1932x1916; FOV: 45 degrees; color fundus image — 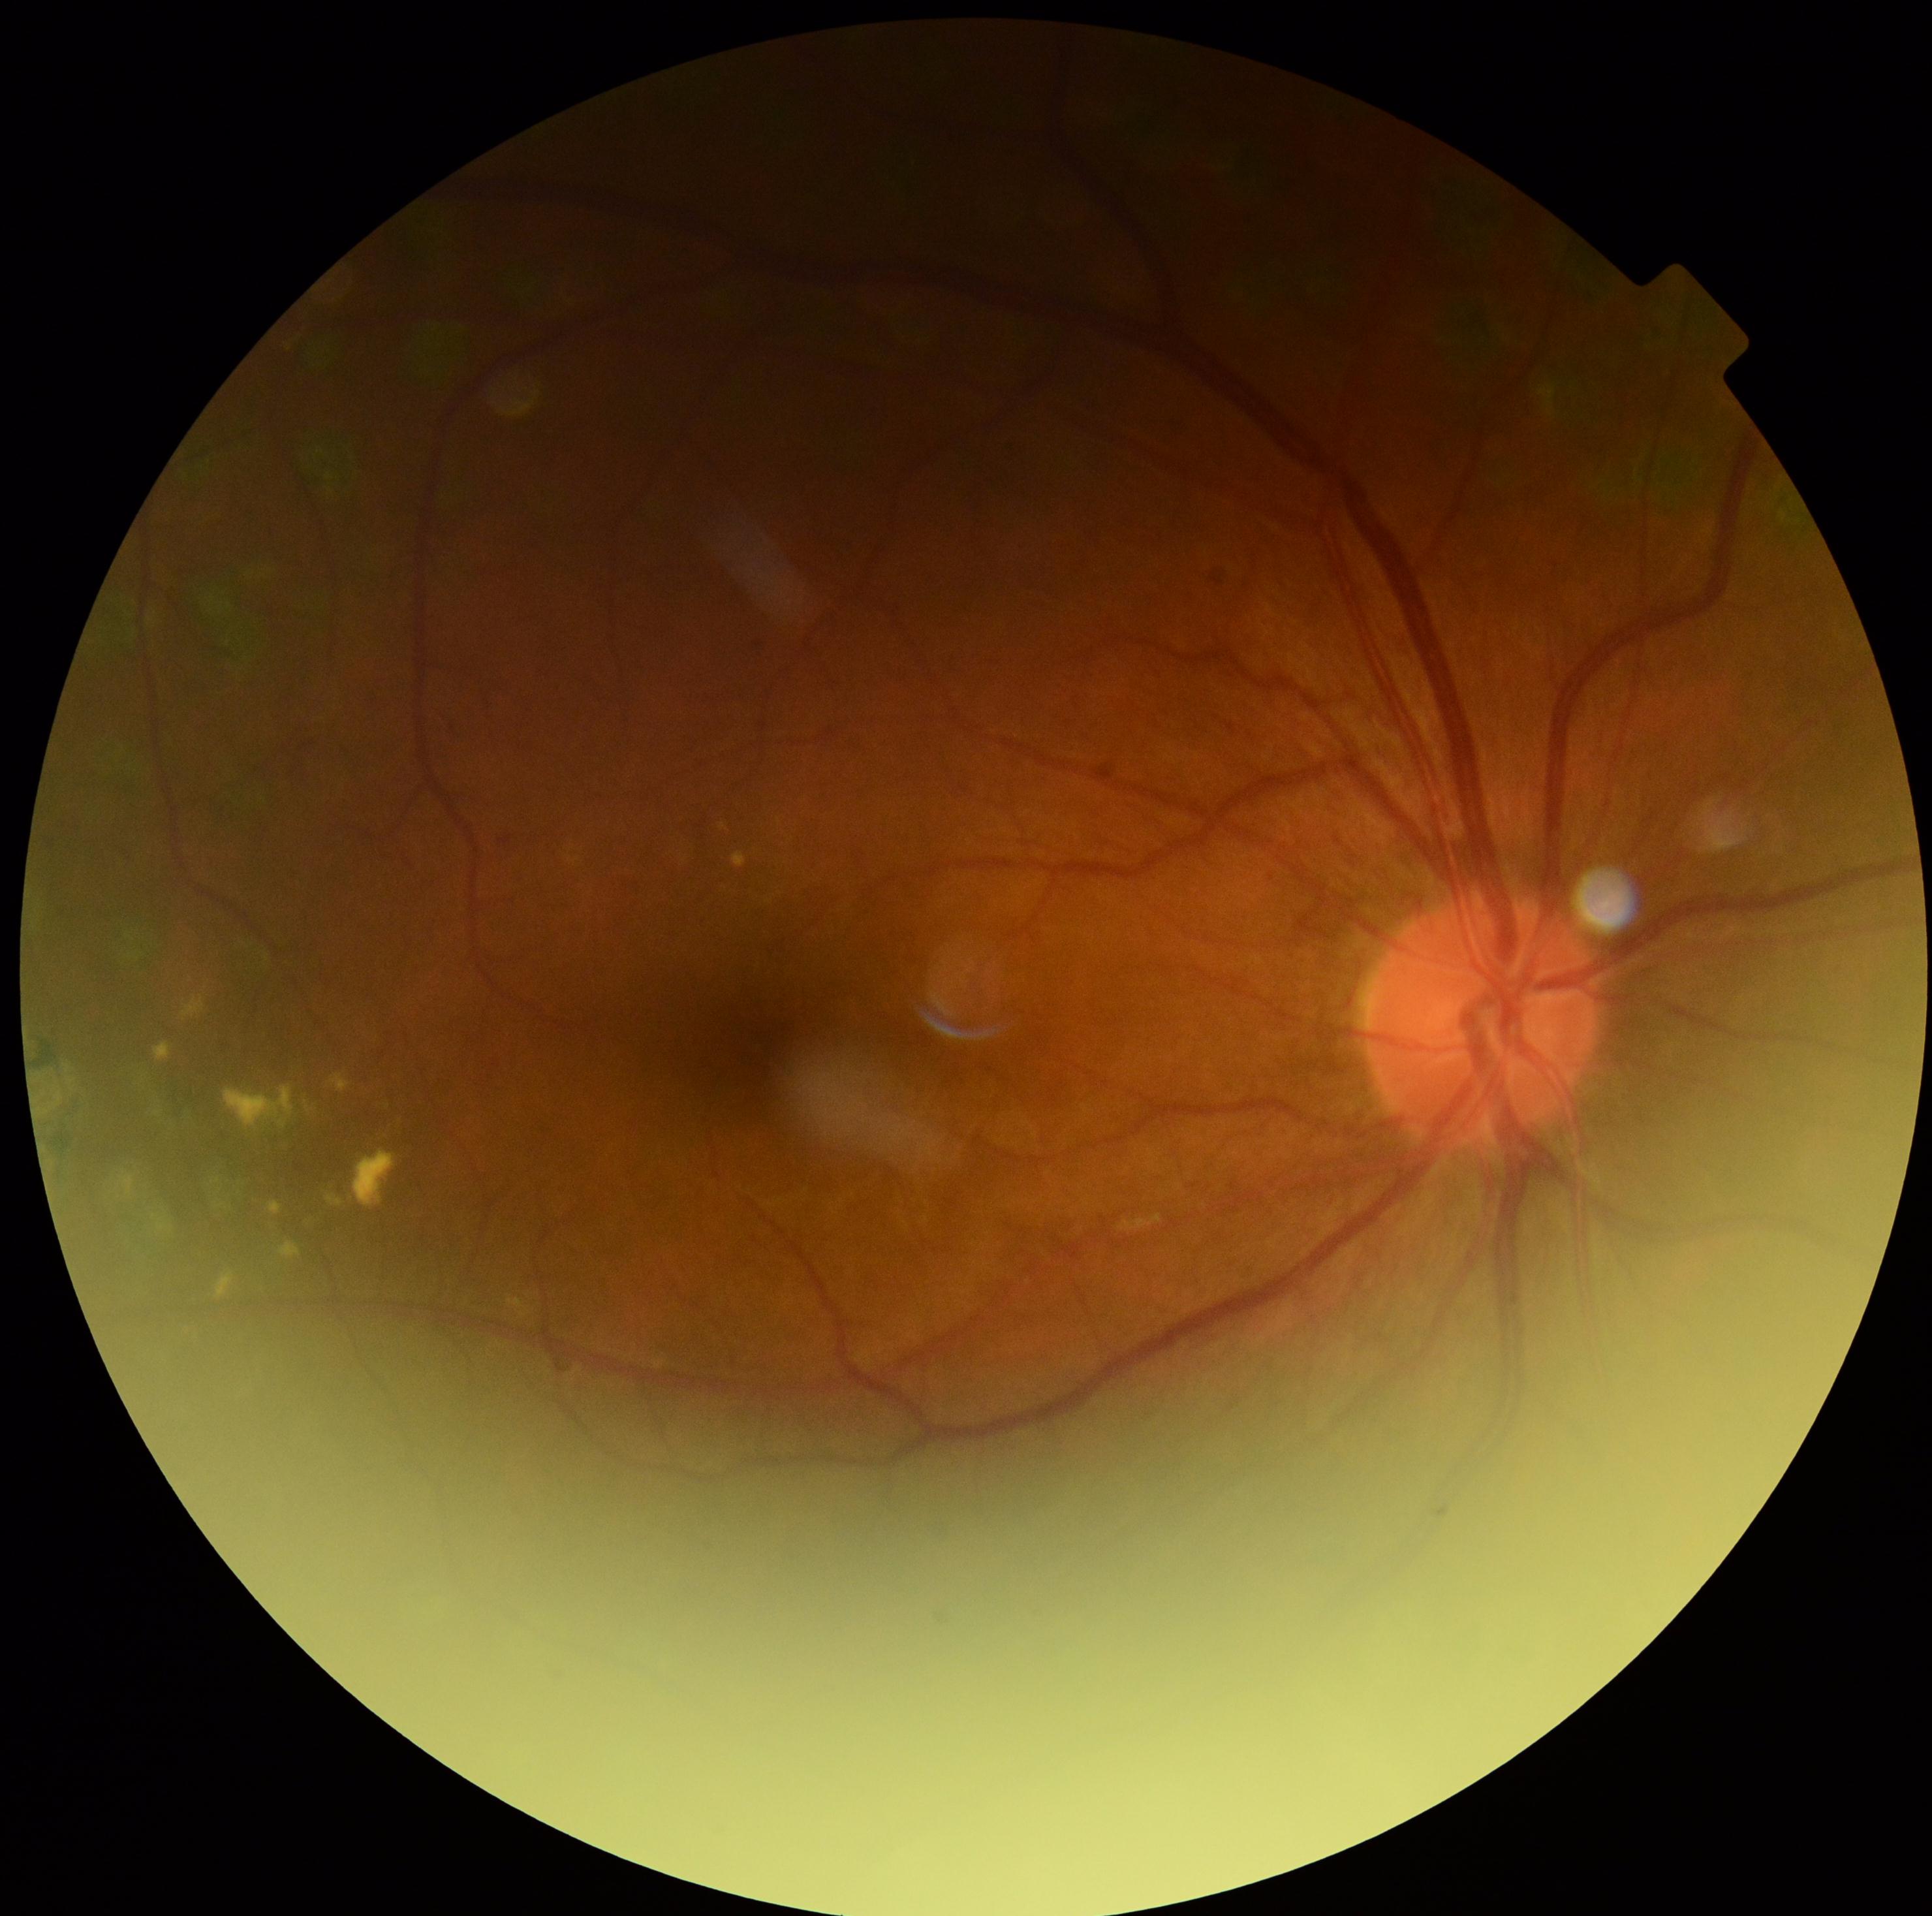 {"dr_category": "non-proliferative diabetic retinopathy", "dr_grade": "2"}